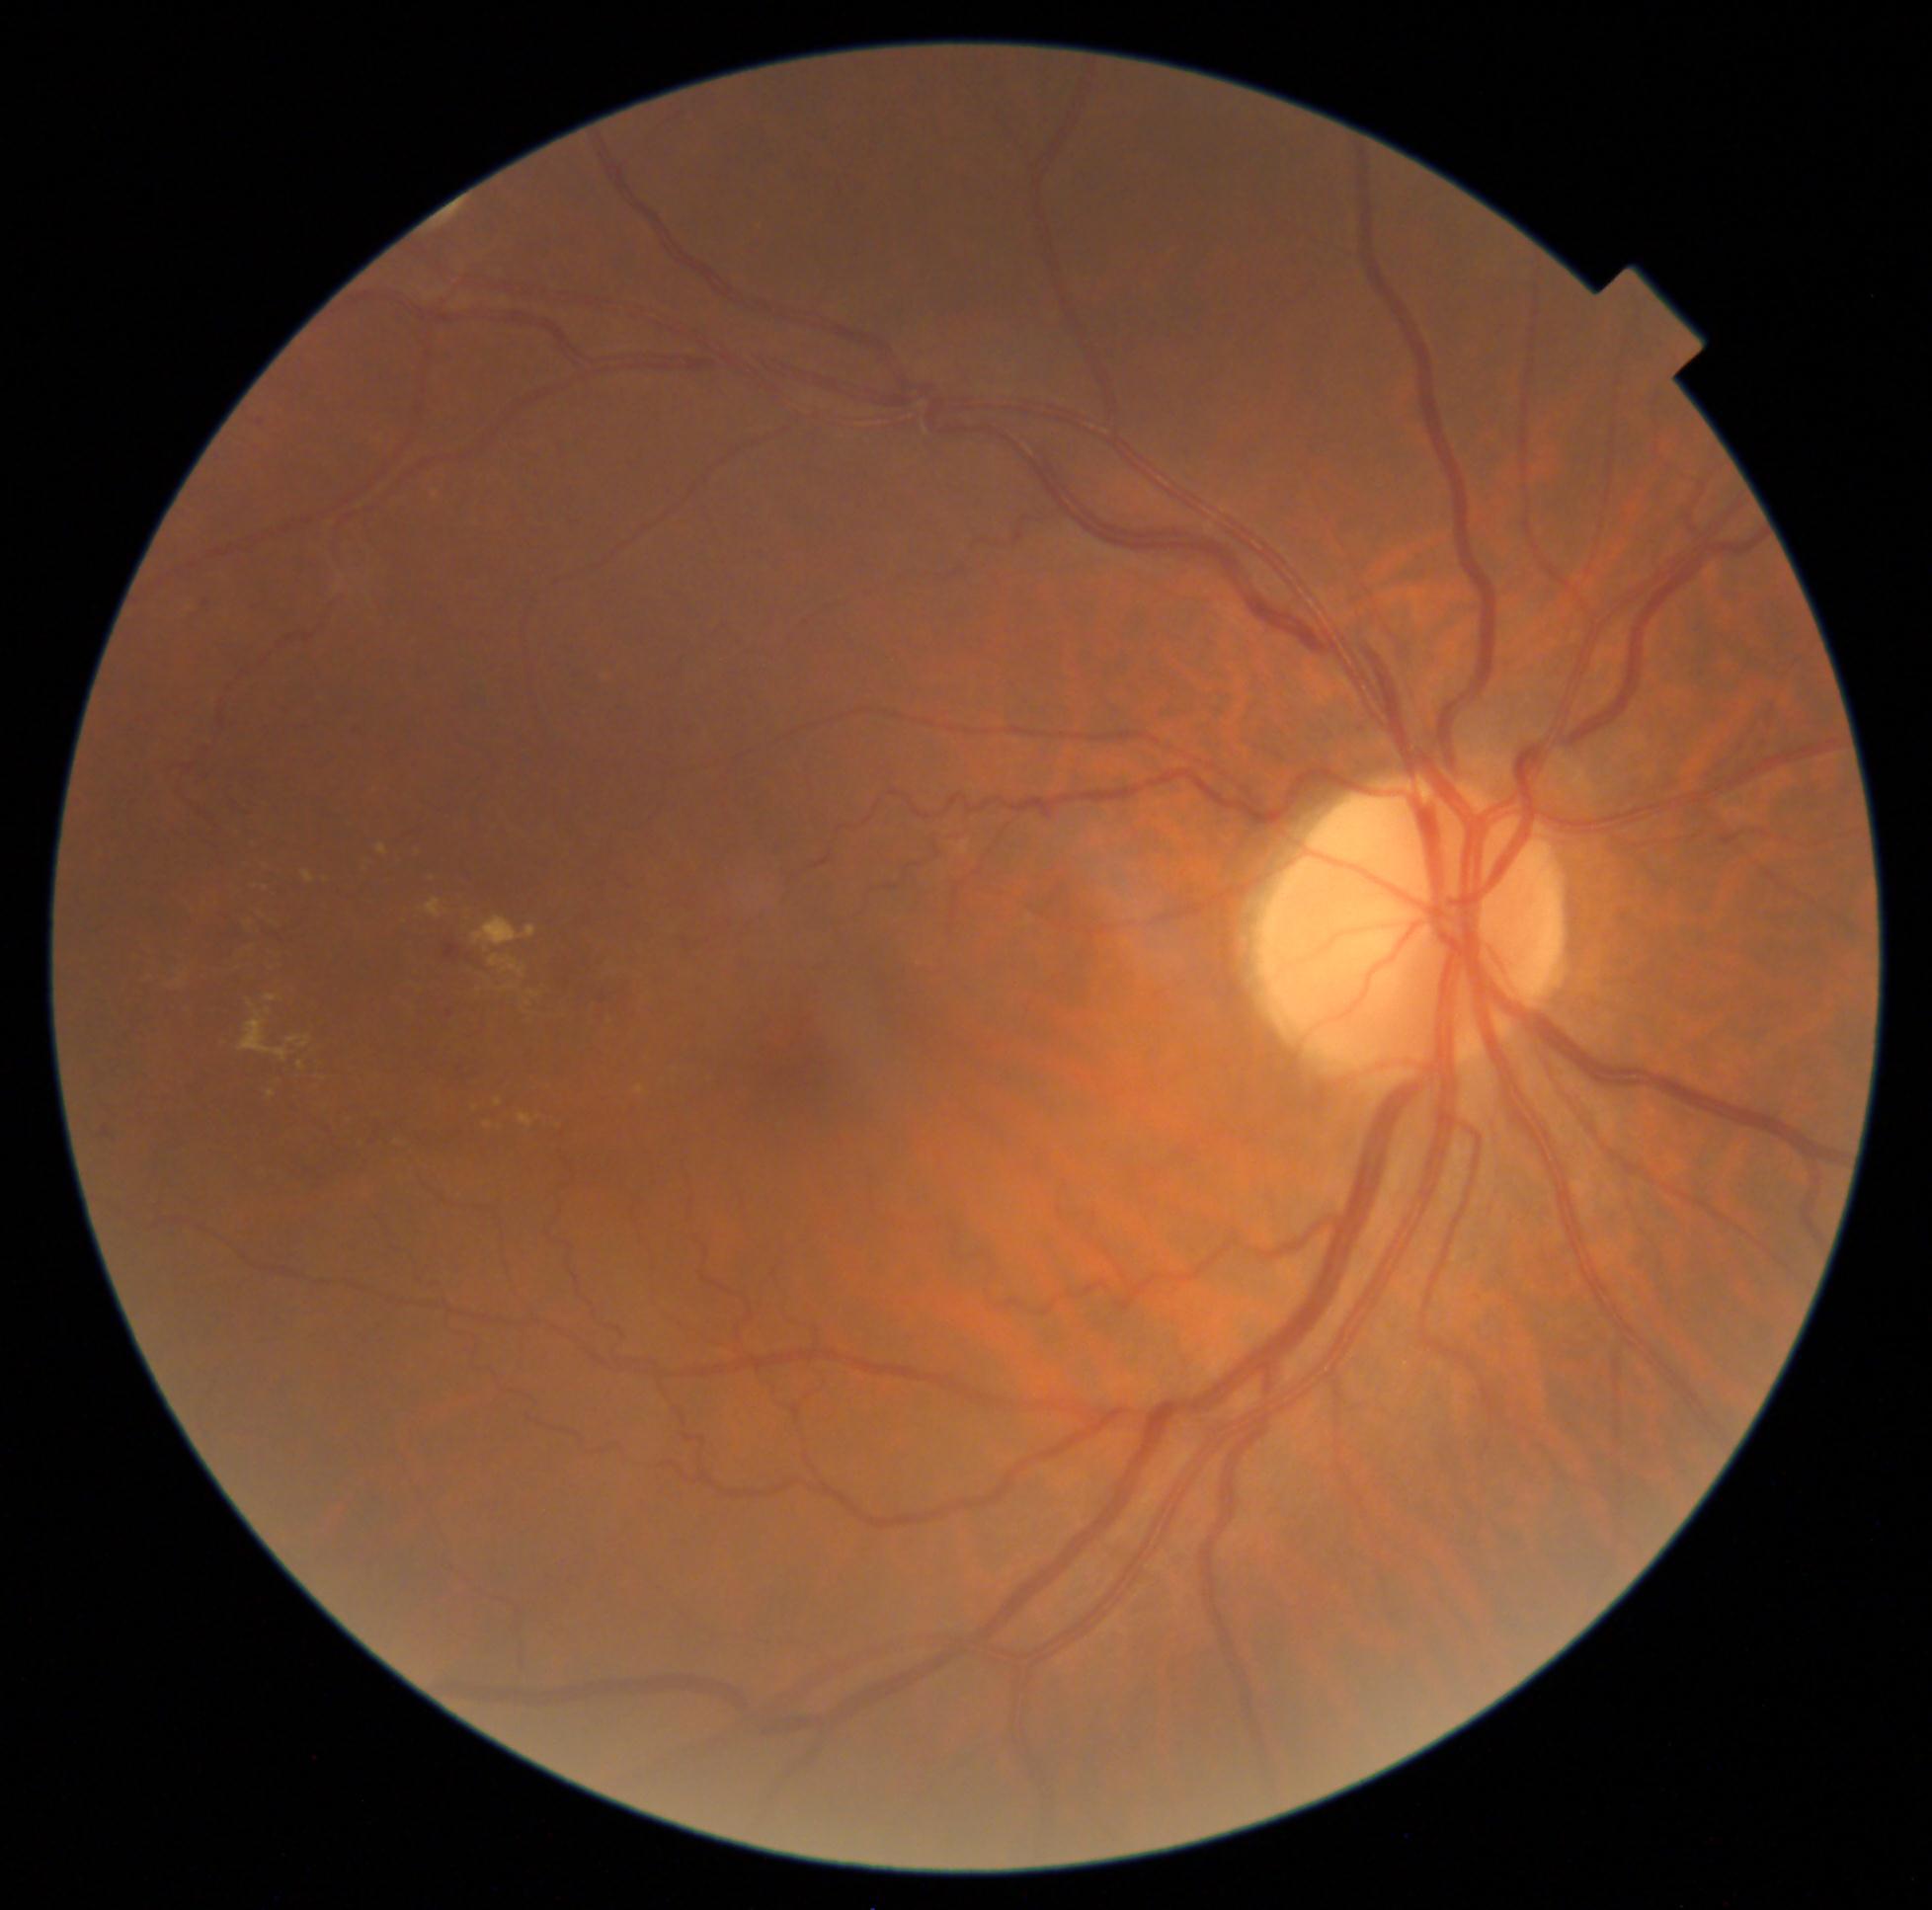

Diabetic retinopathy grade is moderate NPDR (2).